Pediatric wide-field fundus photograph · Phoenix ICON, 100° FOV — 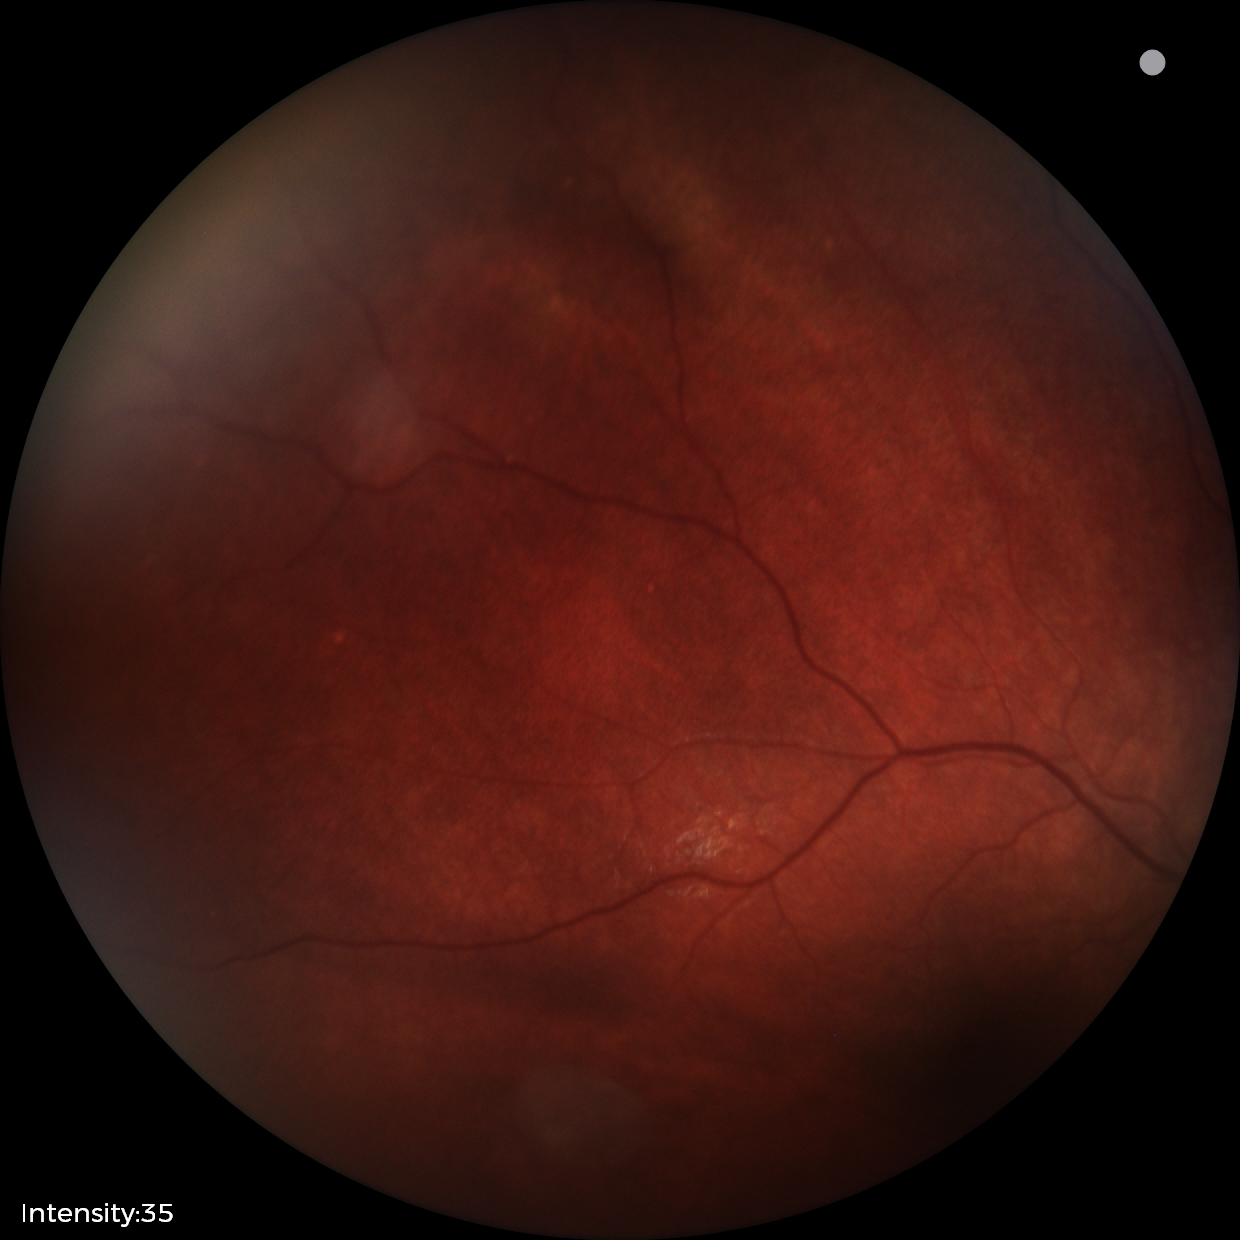
Assessment = retinal astrocytic hamartoma